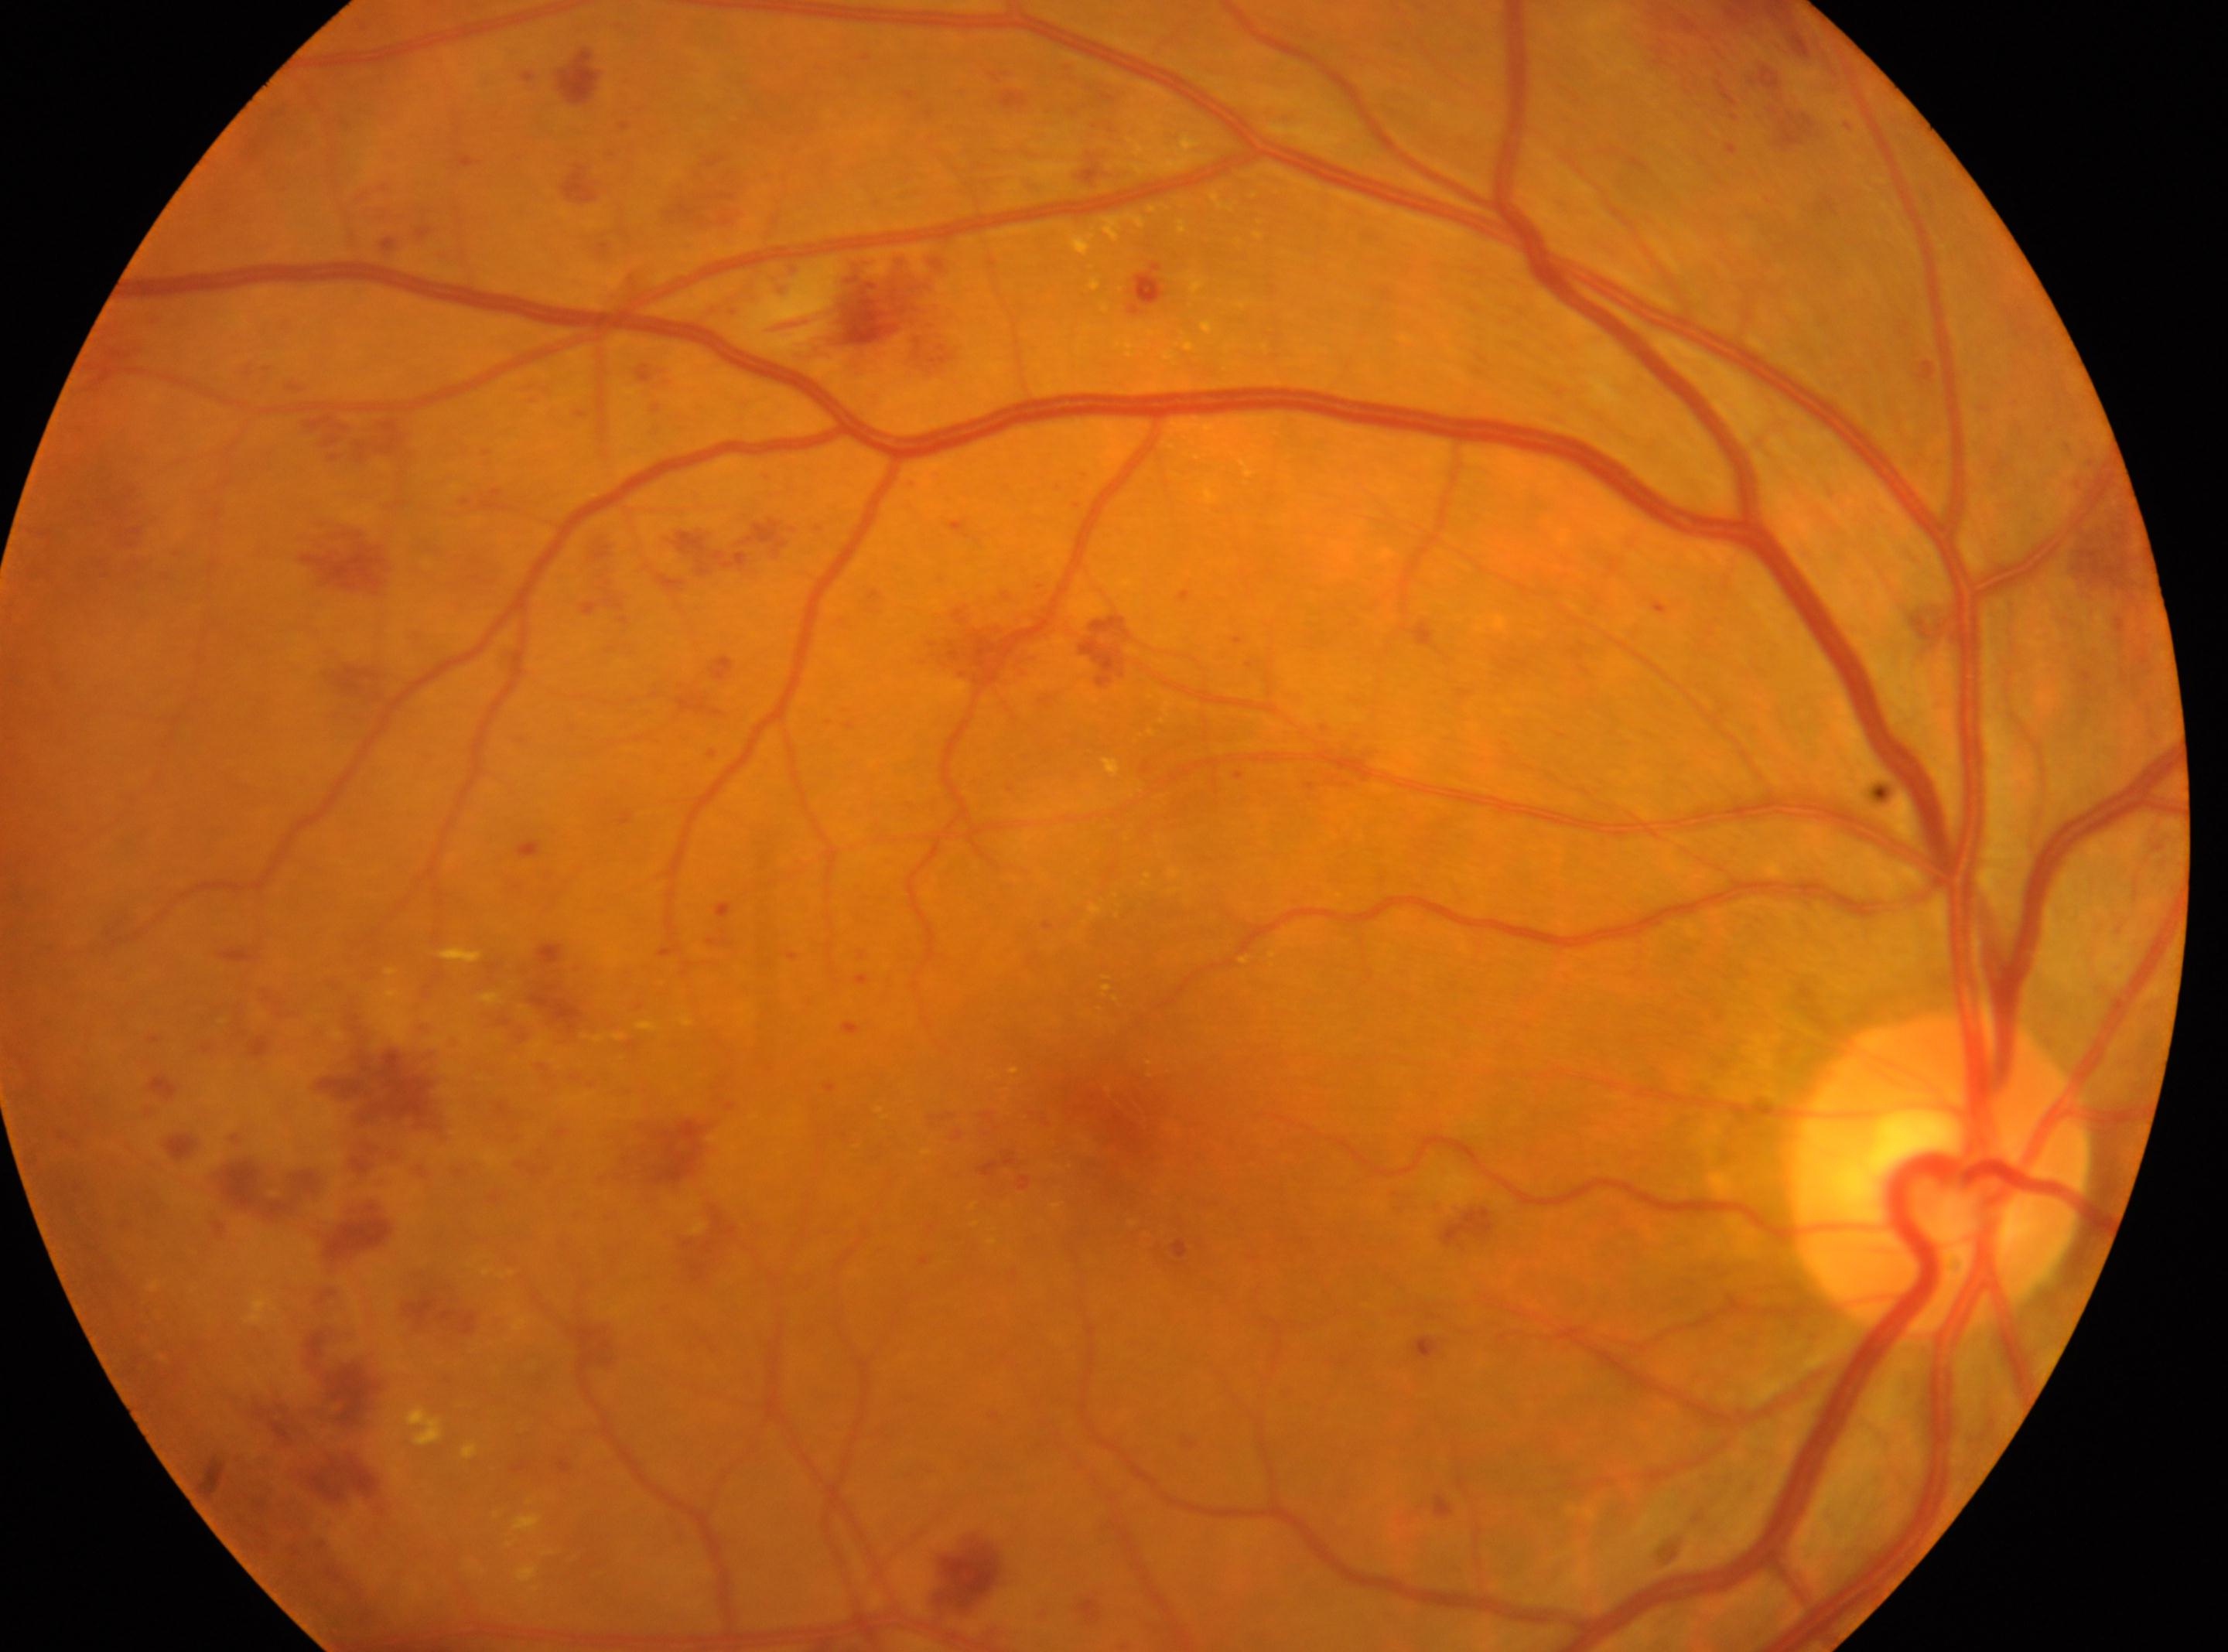

retinopathy grade: 3
fovea centralis: x=1092, y=1129
laterality: oculus dexter
optic disc center: x=1939, y=1173